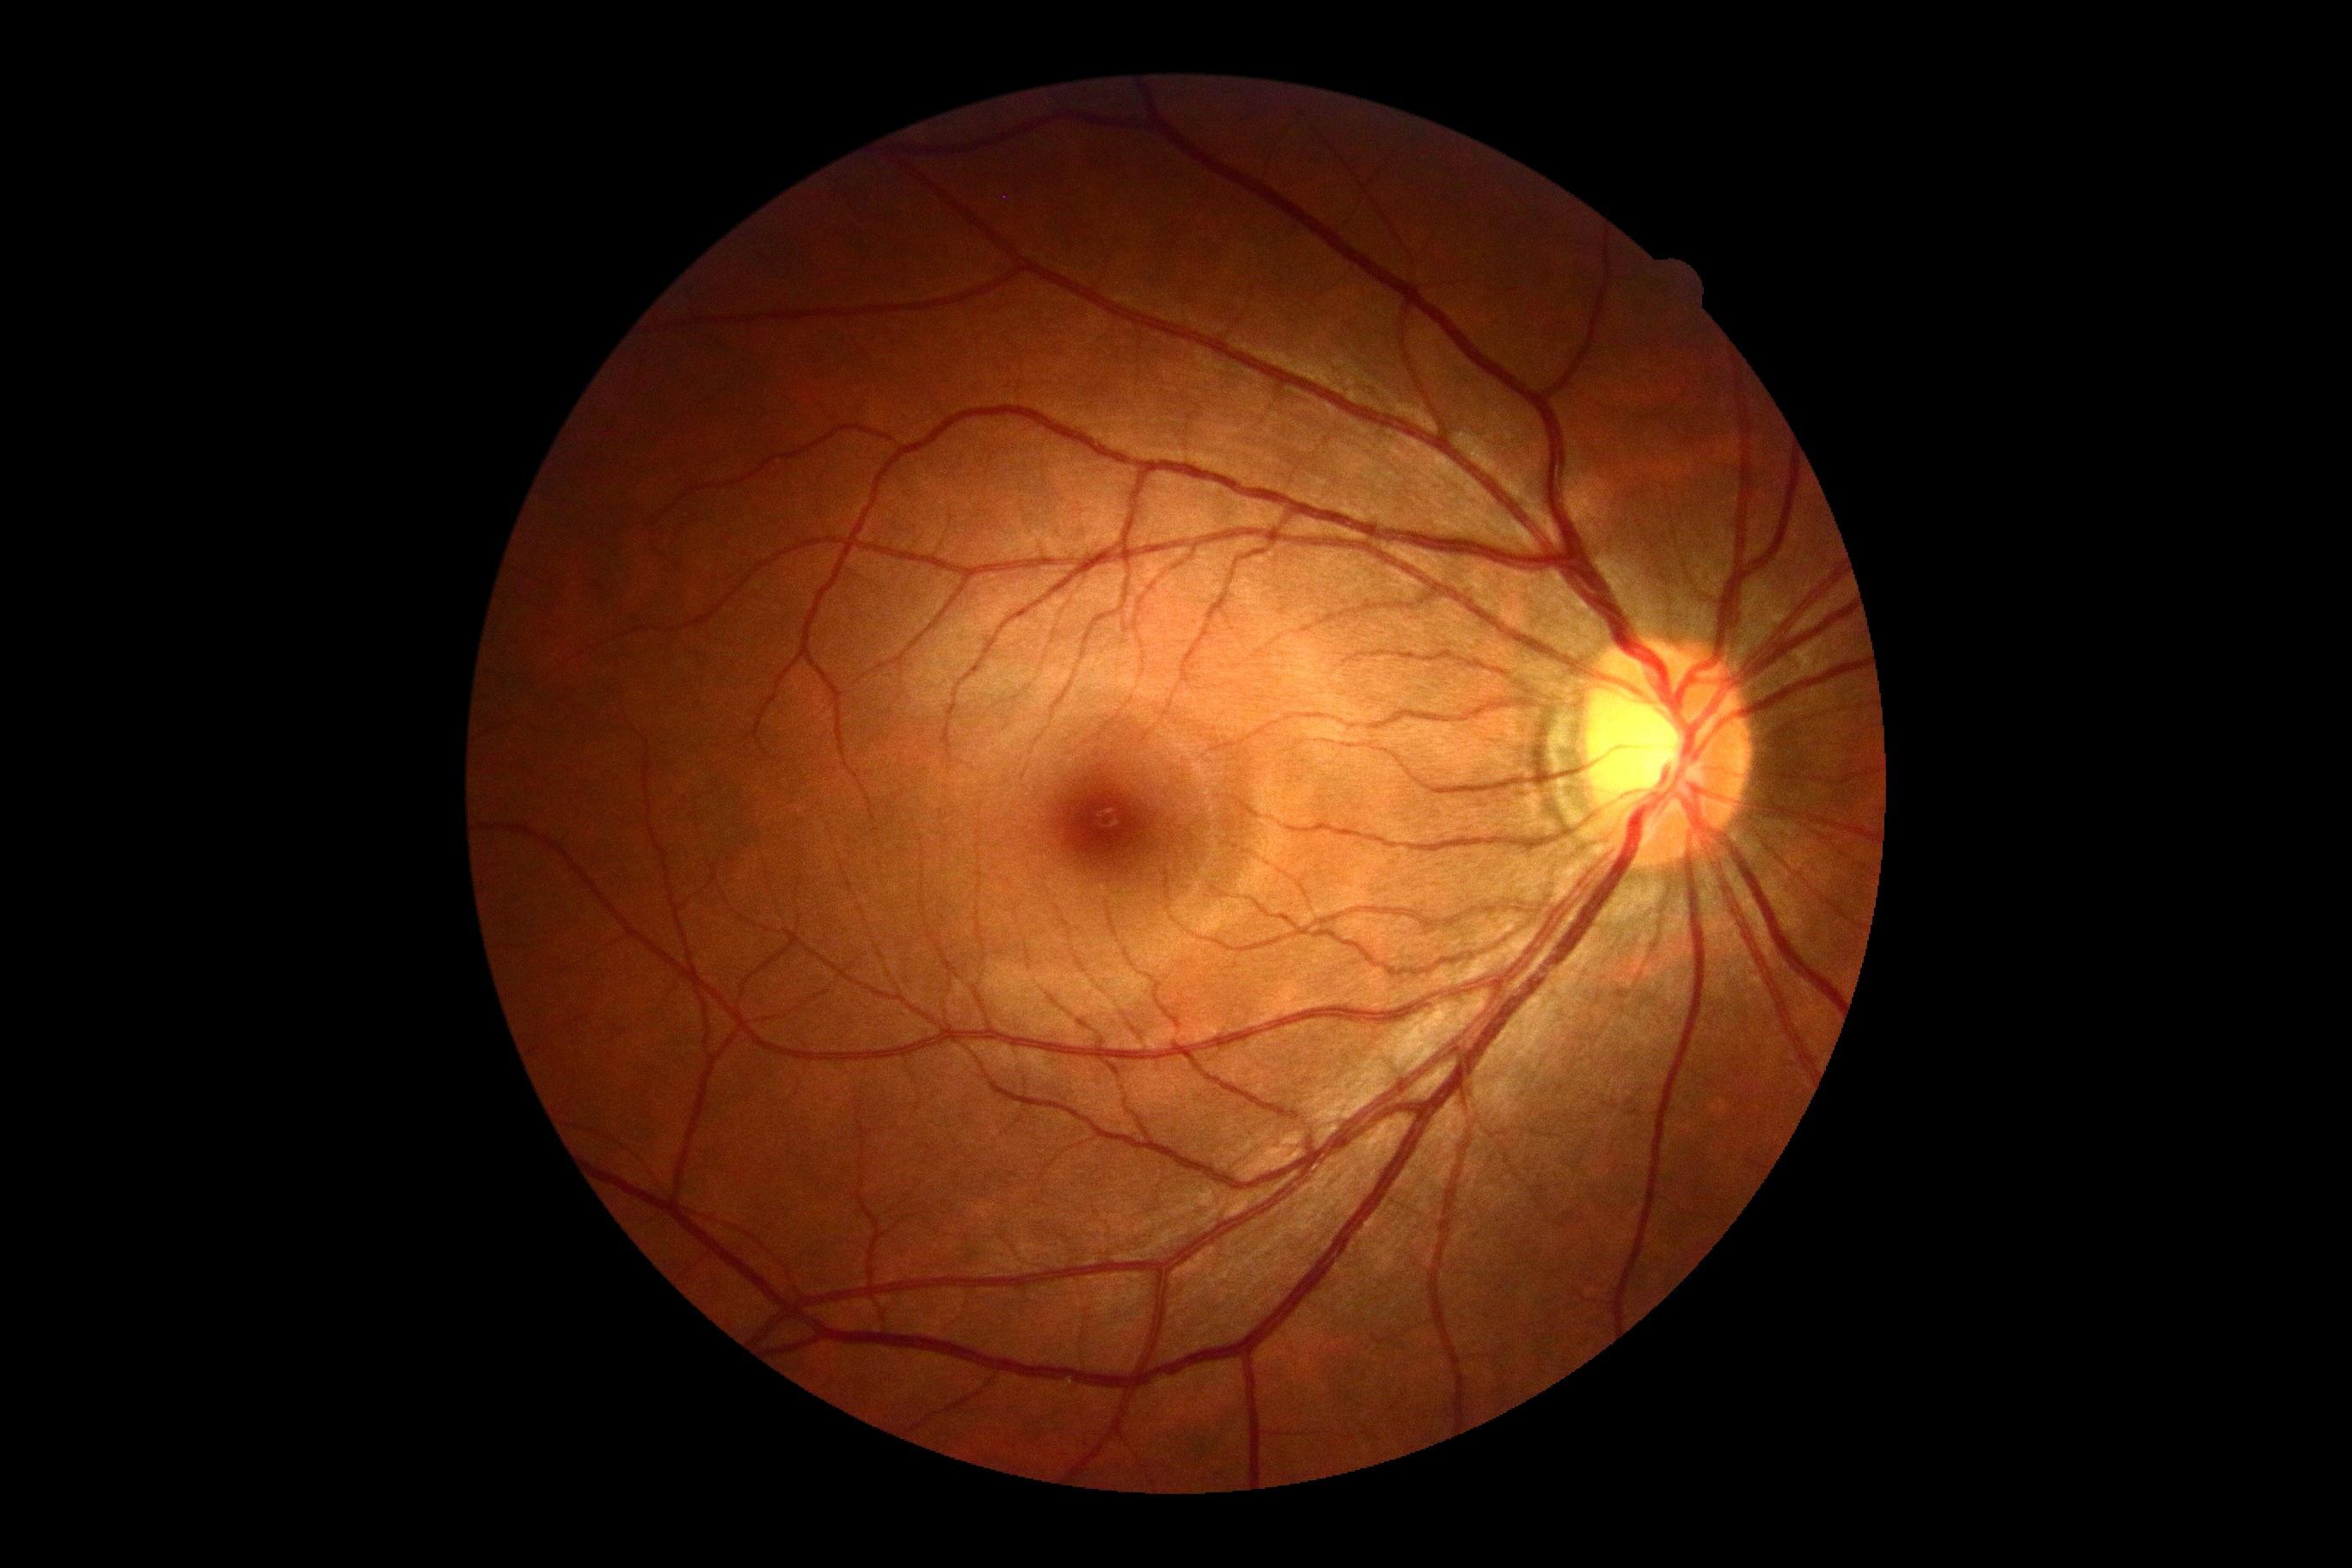

  dr_grade: grade 0